Color fundus image · 45-degree field of view: 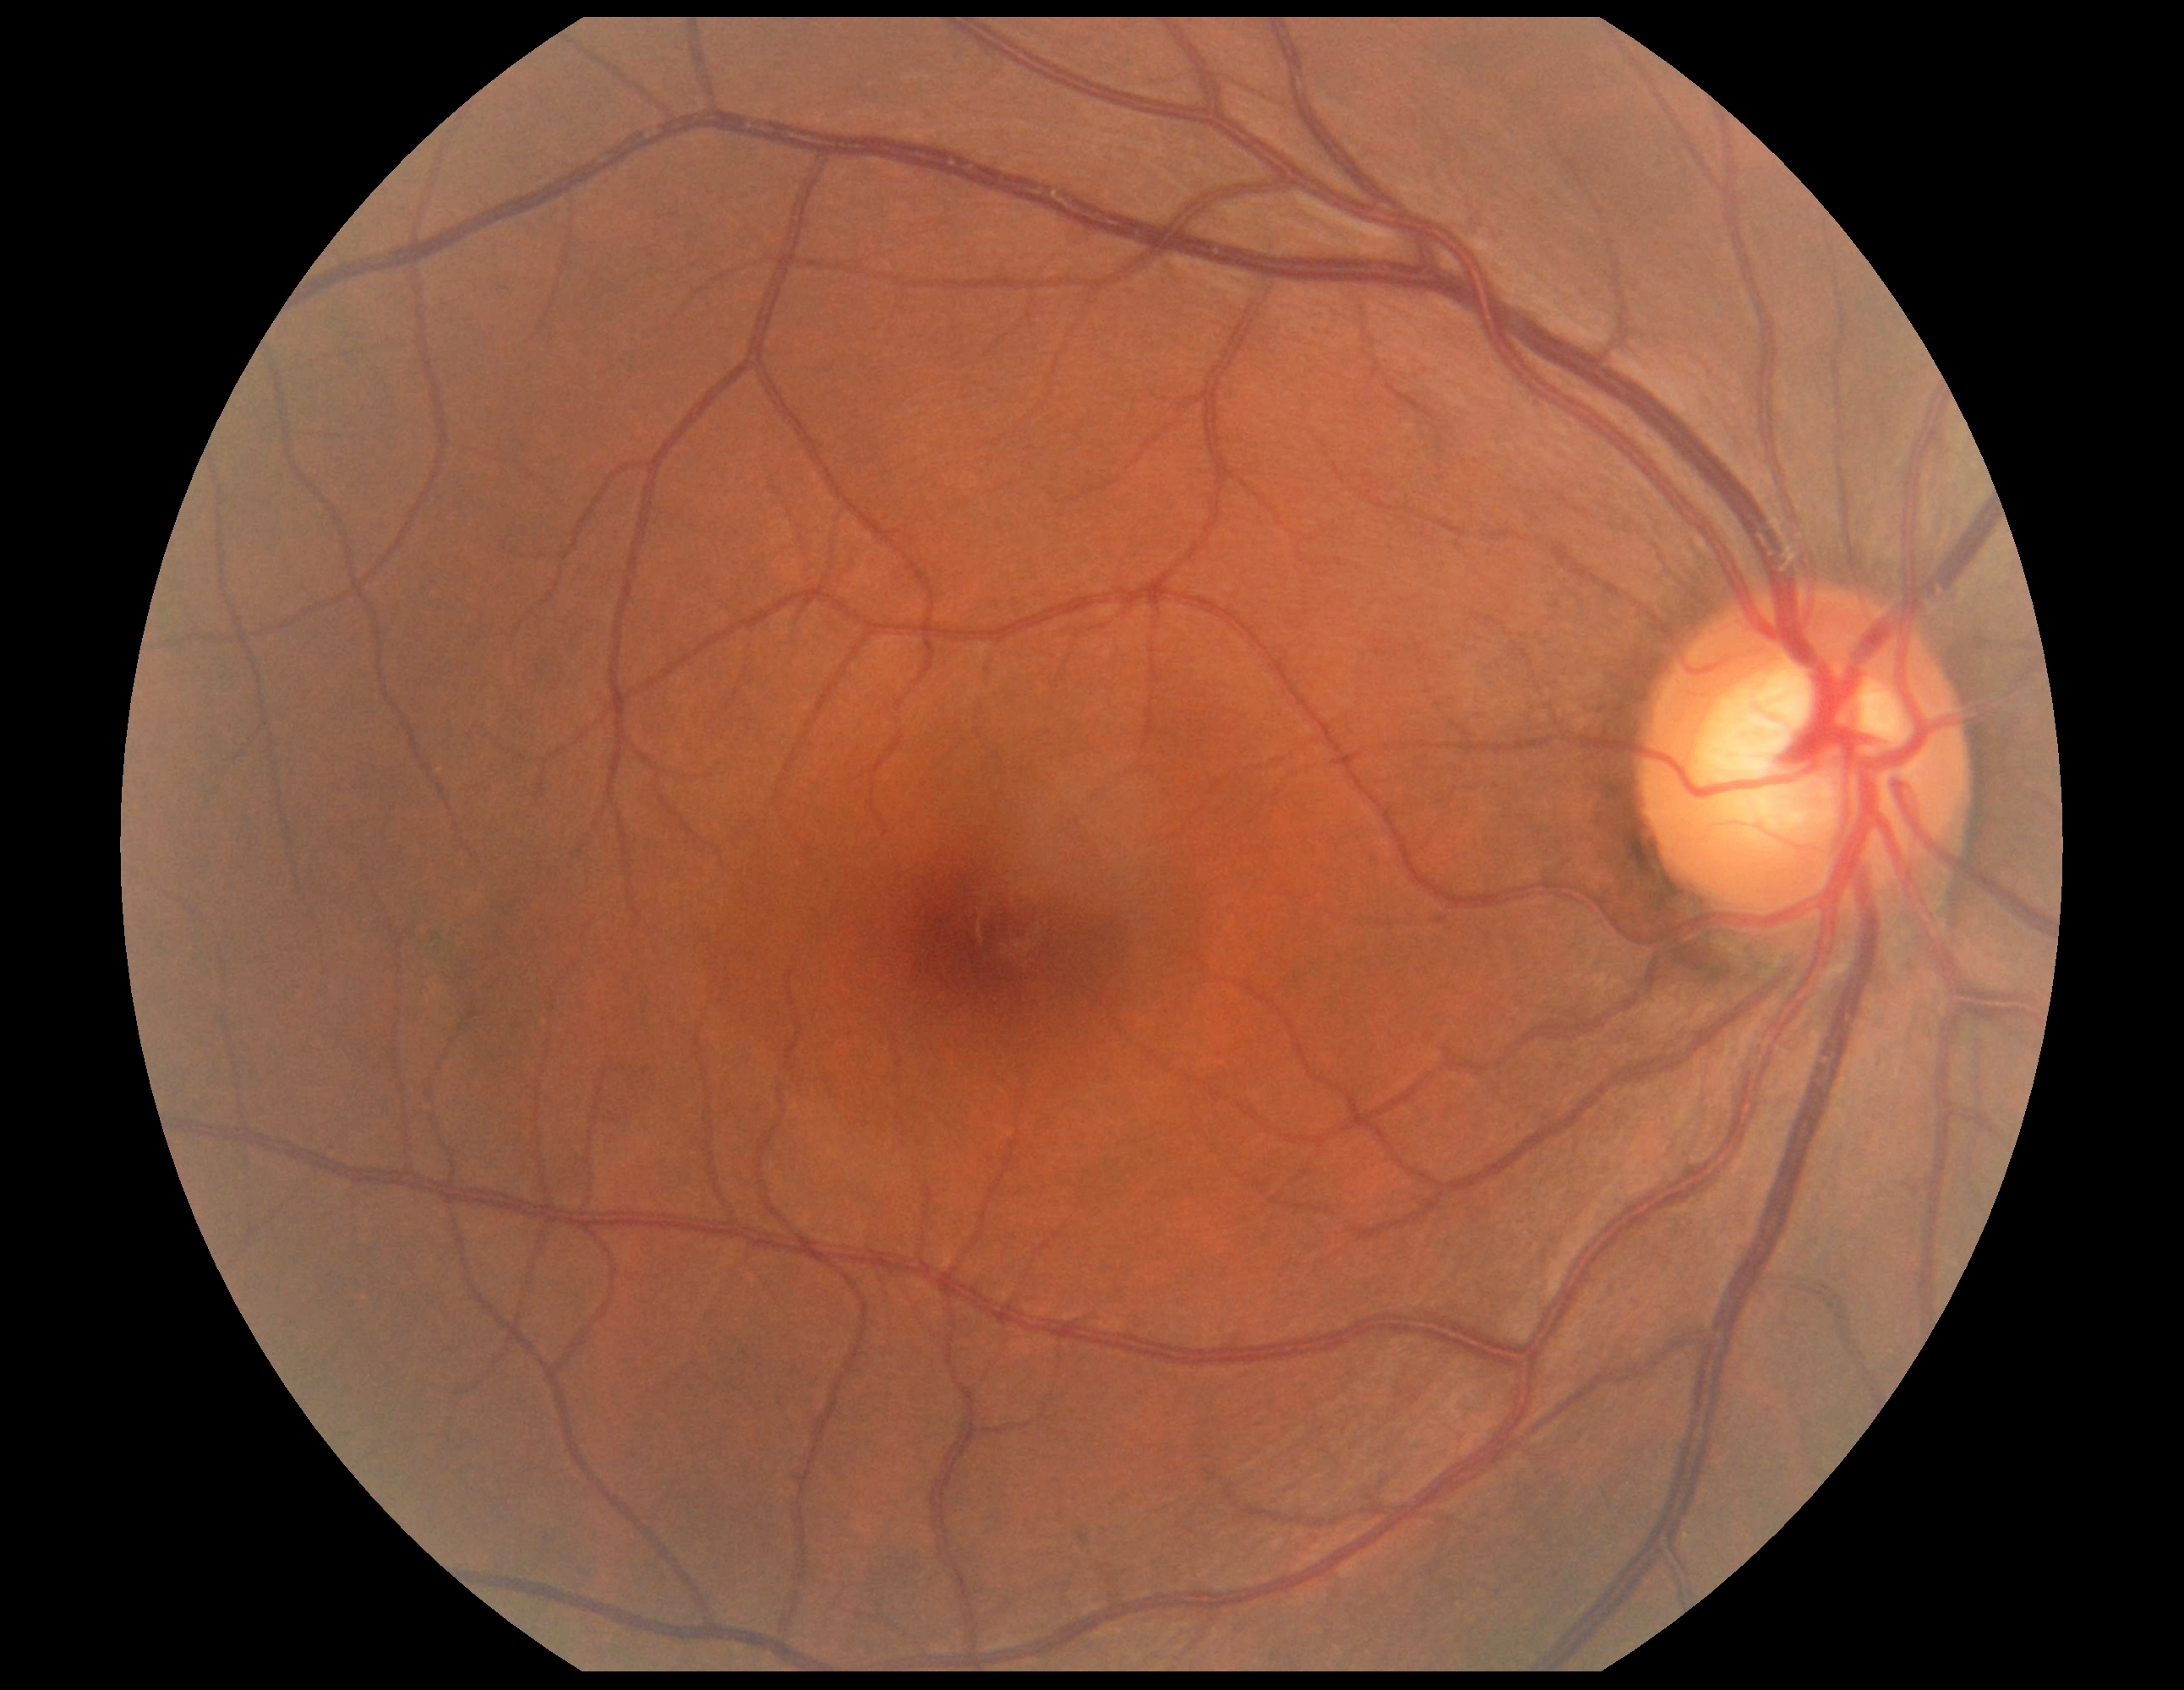
{
  "dr_grade": "0 (no apparent retinopathy) — no visible signs of diabetic retinopathy"
}